Ultra-widefield fundus photograph. 200-degree field of view.
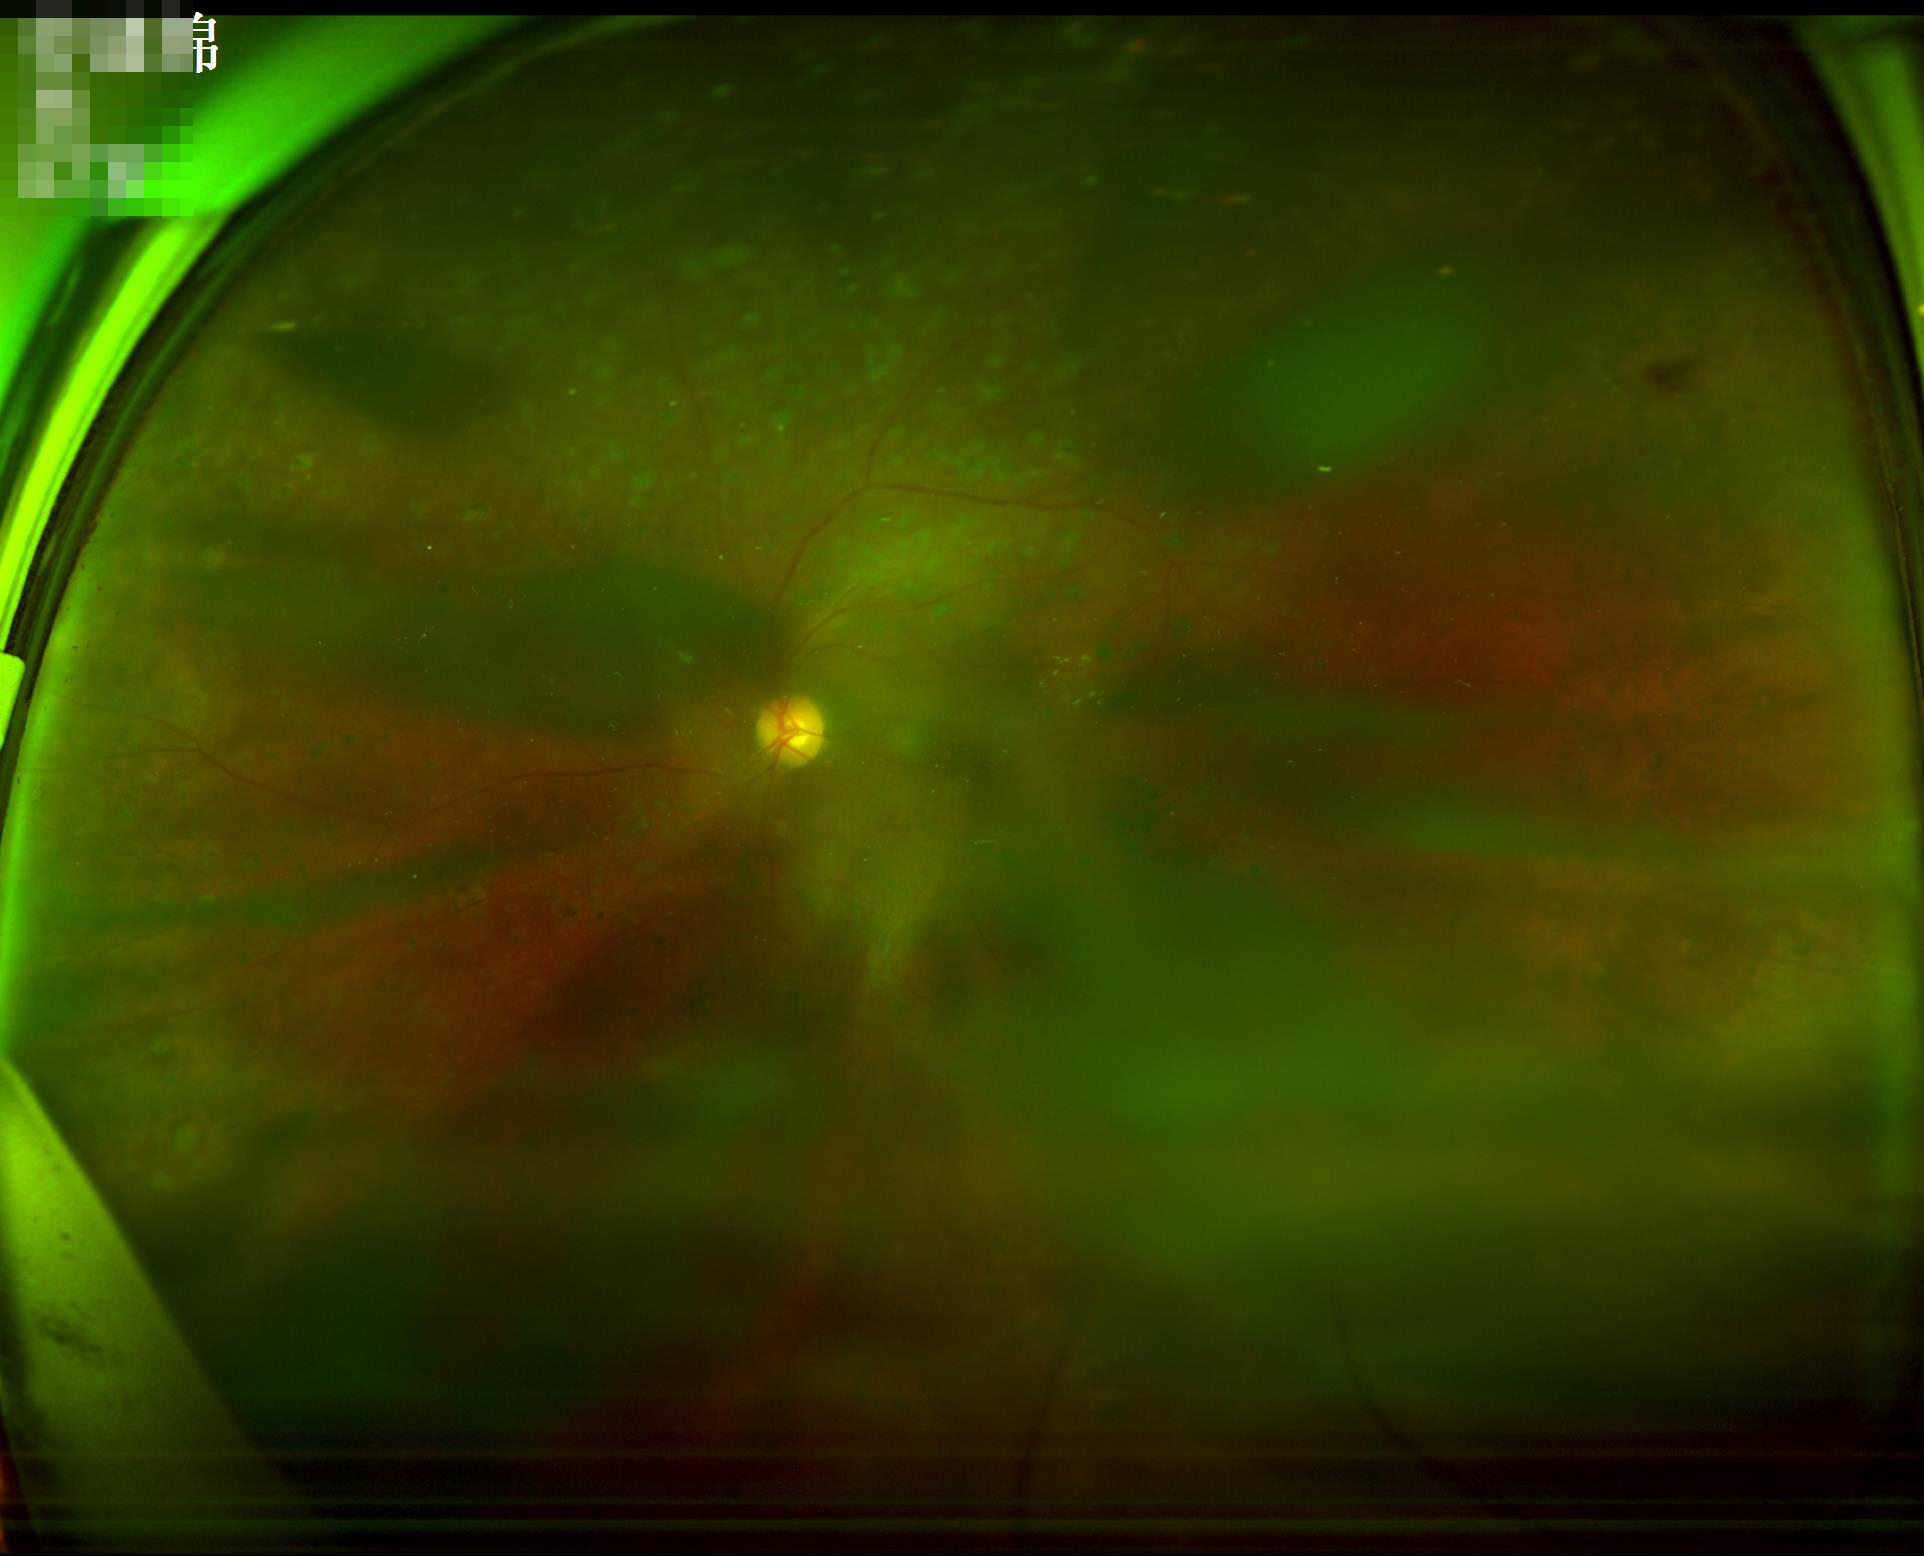 Overall: poor; Contrast: satisfactory; Illumination/color: uneven; Focus: out of focus.